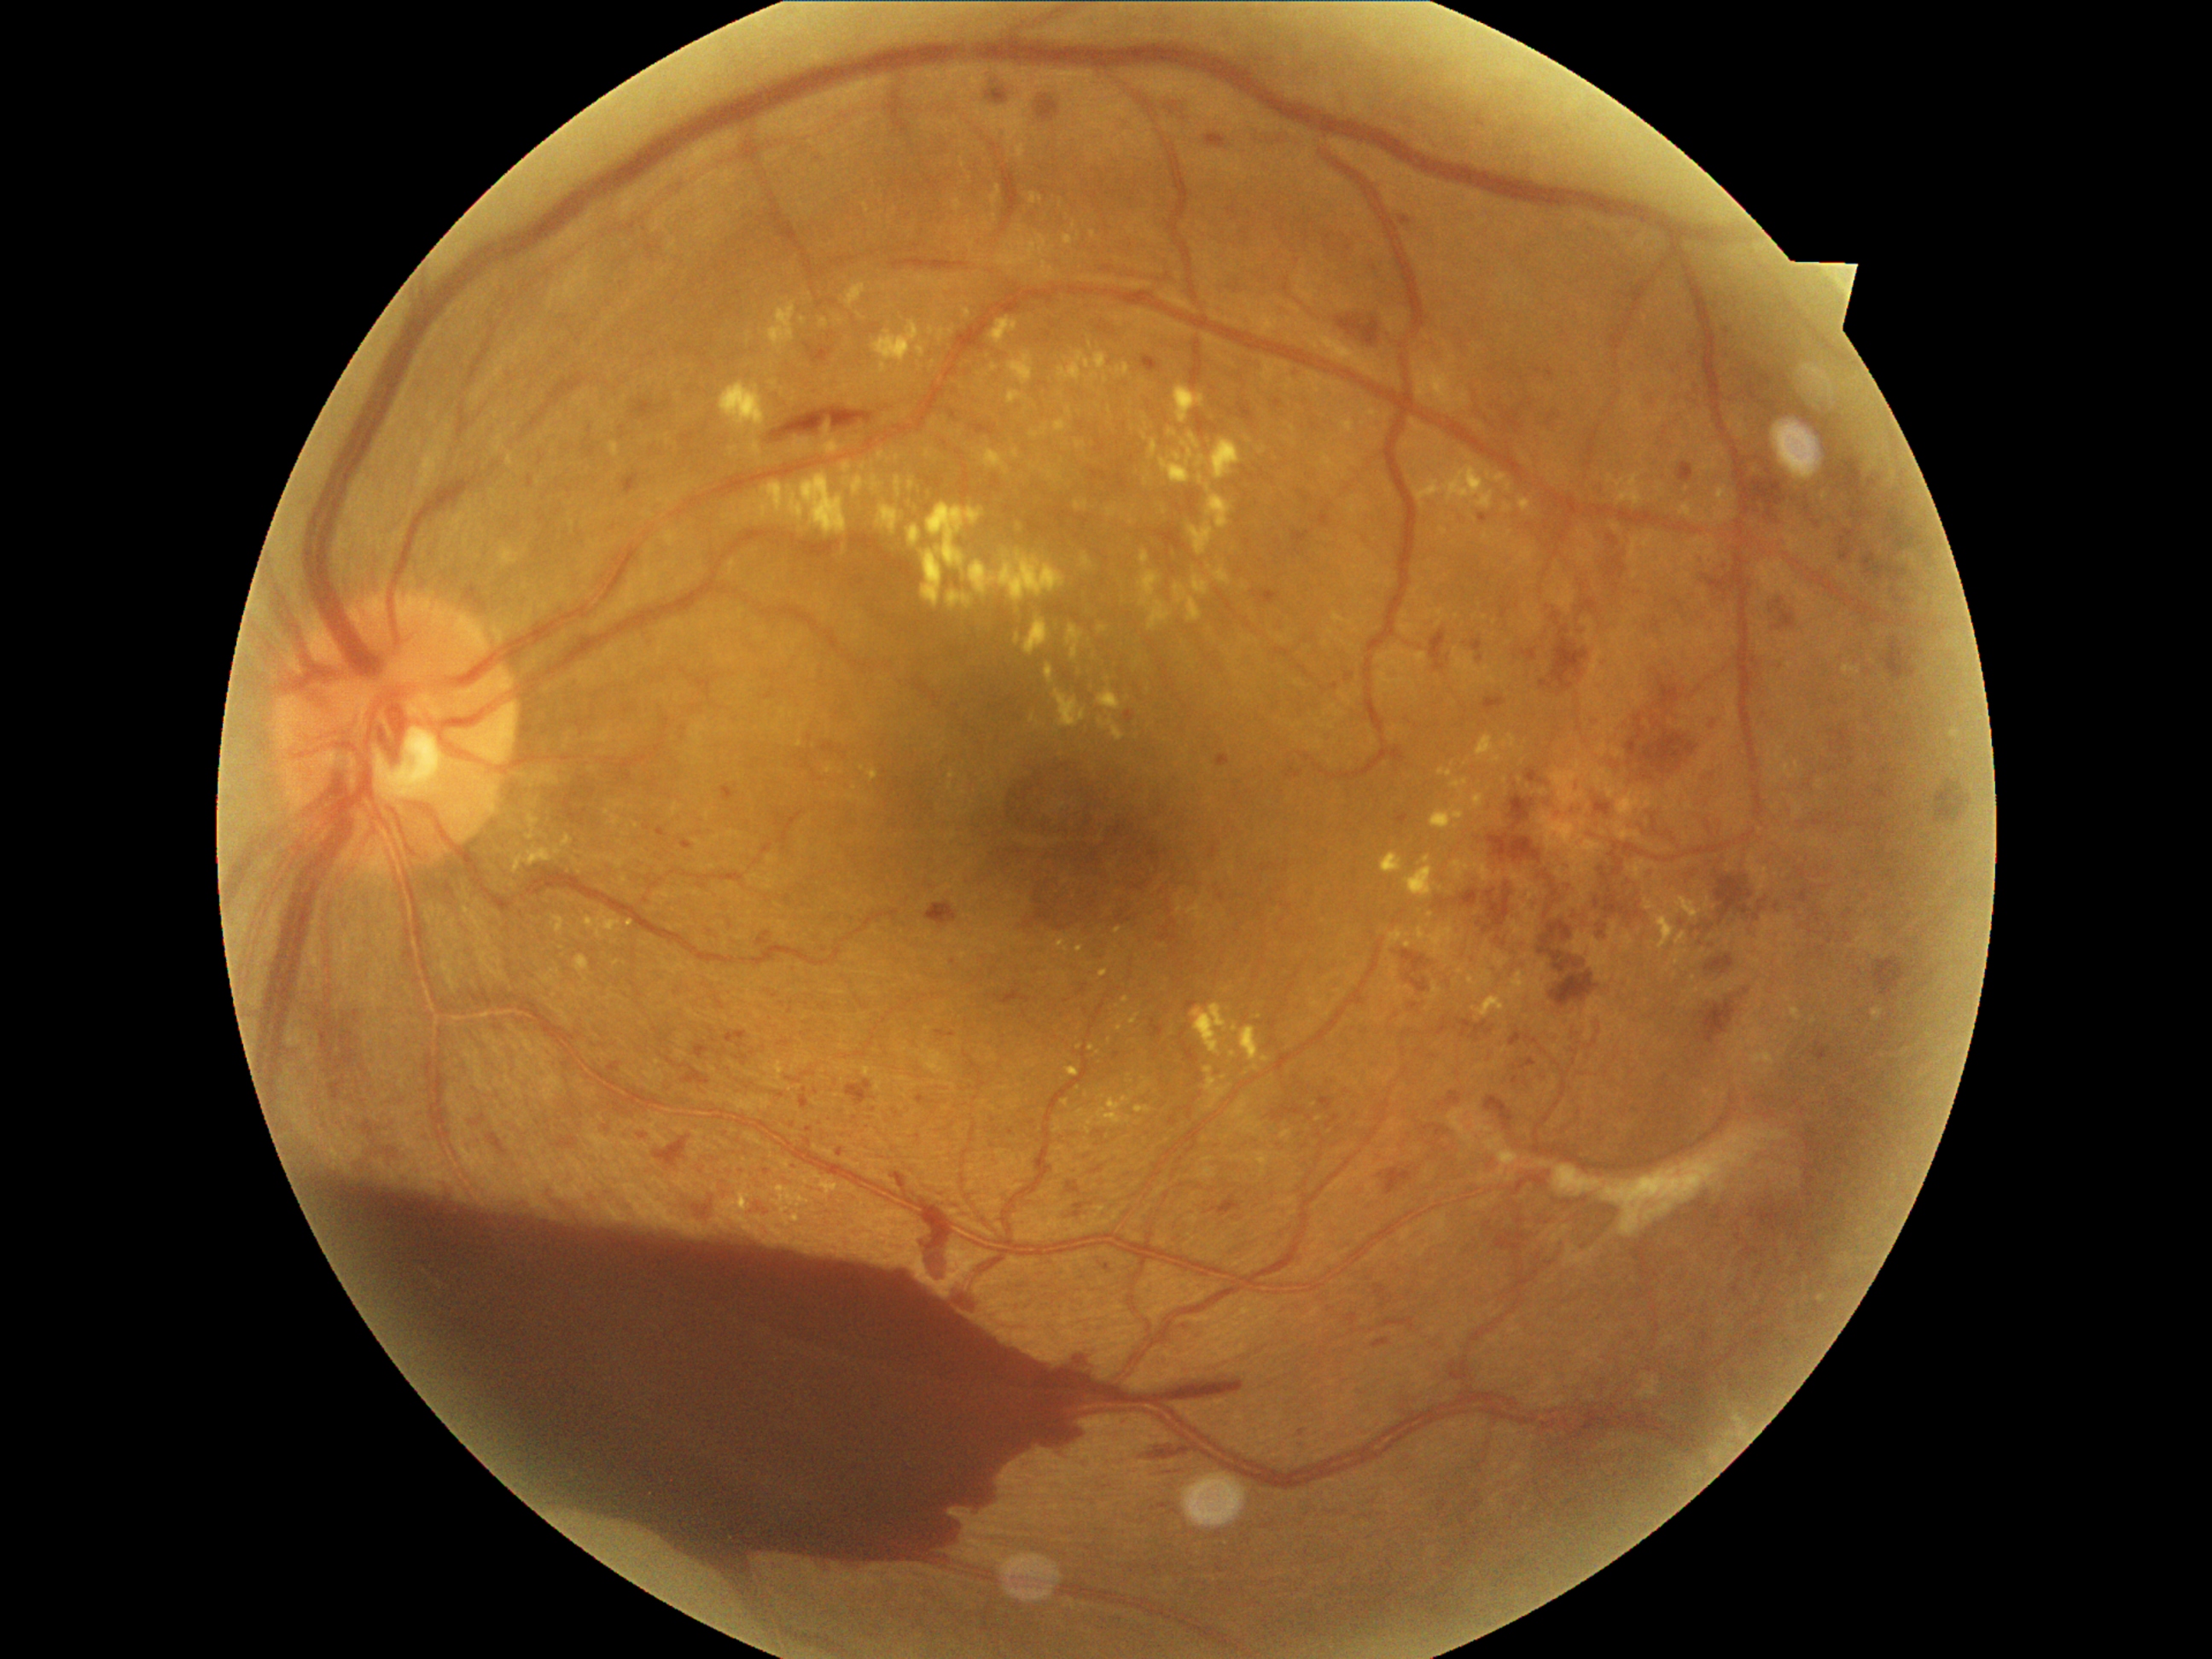

partial: true
dr_grade: 4
lesions:
  he:
    - bbox=[1750, 469, 1786, 523]
    - bbox=[694, 1201, 714, 1225]
    - bbox=[1539, 923, 1585, 974]
    - bbox=[1545, 873, 1569, 909]
    - bbox=[1750, 508, 1759, 513]
    - bbox=[1716, 876, 1754, 926]
    - bbox=[1868, 957, 1906, 999]
    - bbox=[1935, 781, 1965, 824]
    - bbox=[1462, 890, 1479, 907]
    - bbox=[318, 1170, 1245, 1578]
    - bbox=[1051, 1436, 1086, 1462]
    - bbox=[1827, 457, 1877, 521]
    - bbox=[655, 1136, 692, 1165]
    - bbox=[1503, 412, 1523, 434]
    - bbox=[1883, 637, 1918, 680]
    - bbox=[1658, 680, 1682, 707]
    - bbox=[1510, 796, 1537, 832]
    - bbox=[769, 407, 876, 445]
  he_small_centers:
    - point(1762, 460)
  se: []
  ex:
    - bbox=[1366, 410, 1378, 419]
    - bbox=[743, 472, 847, 535]
    - bbox=[752, 443, 760, 457]
    - bbox=[1199, 474, 1233, 530]
    - bbox=[878, 451, 892, 462]
    - bbox=[1377, 1018, 1387, 1023]
    - bbox=[494, 436, 504, 453]
    - bbox=[981, 223, 991, 230]
    - bbox=[1716, 487, 1738, 523]
    - bbox=[1049, 467, 1056, 479]
    - bbox=[1056, 690, 1086, 728]
    - bbox=[552, 916, 564, 934]
    - bbox=[907, 525, 923, 547]
    - bbox=[824, 378, 849, 399]
  ex_small_centers:
    - point(1019, 526)
    - point(893, 396)
    - point(1825, 497)
    - point(934, 424)
    - point(1443, 531)
    - point(1225, 1077)
  ma:
    - bbox=[1540, 682, 1554, 689]
    - bbox=[528, 477, 537, 489]
    - bbox=[936, 1032, 948, 1037]
    - bbox=[1179, 1325, 1189, 1337]
    - bbox=[632, 399, 663, 419]
    - bbox=[330, 1078, 347, 1100]
    - bbox=[1774, 610, 1796, 631]
    - bbox=[1076, 1204, 1085, 1209]
    - bbox=[1216, 755, 1230, 767]
    - bbox=[696, 1045, 711, 1059]
    - bbox=[1397, 813, 1409, 825]
    - bbox=[894, 1172, 907, 1190]
    - bbox=[1863, 552, 1909, 585]
    - bbox=[1001, 132, 1010, 141]
    - bbox=[1813, 1042, 1829, 1062]
  ma_small_centers:
    - point(1077, 1215)
    - point(1573, 810)
    - point(1756, 917)
    - point(1747, 990)
    - point(647, 828)